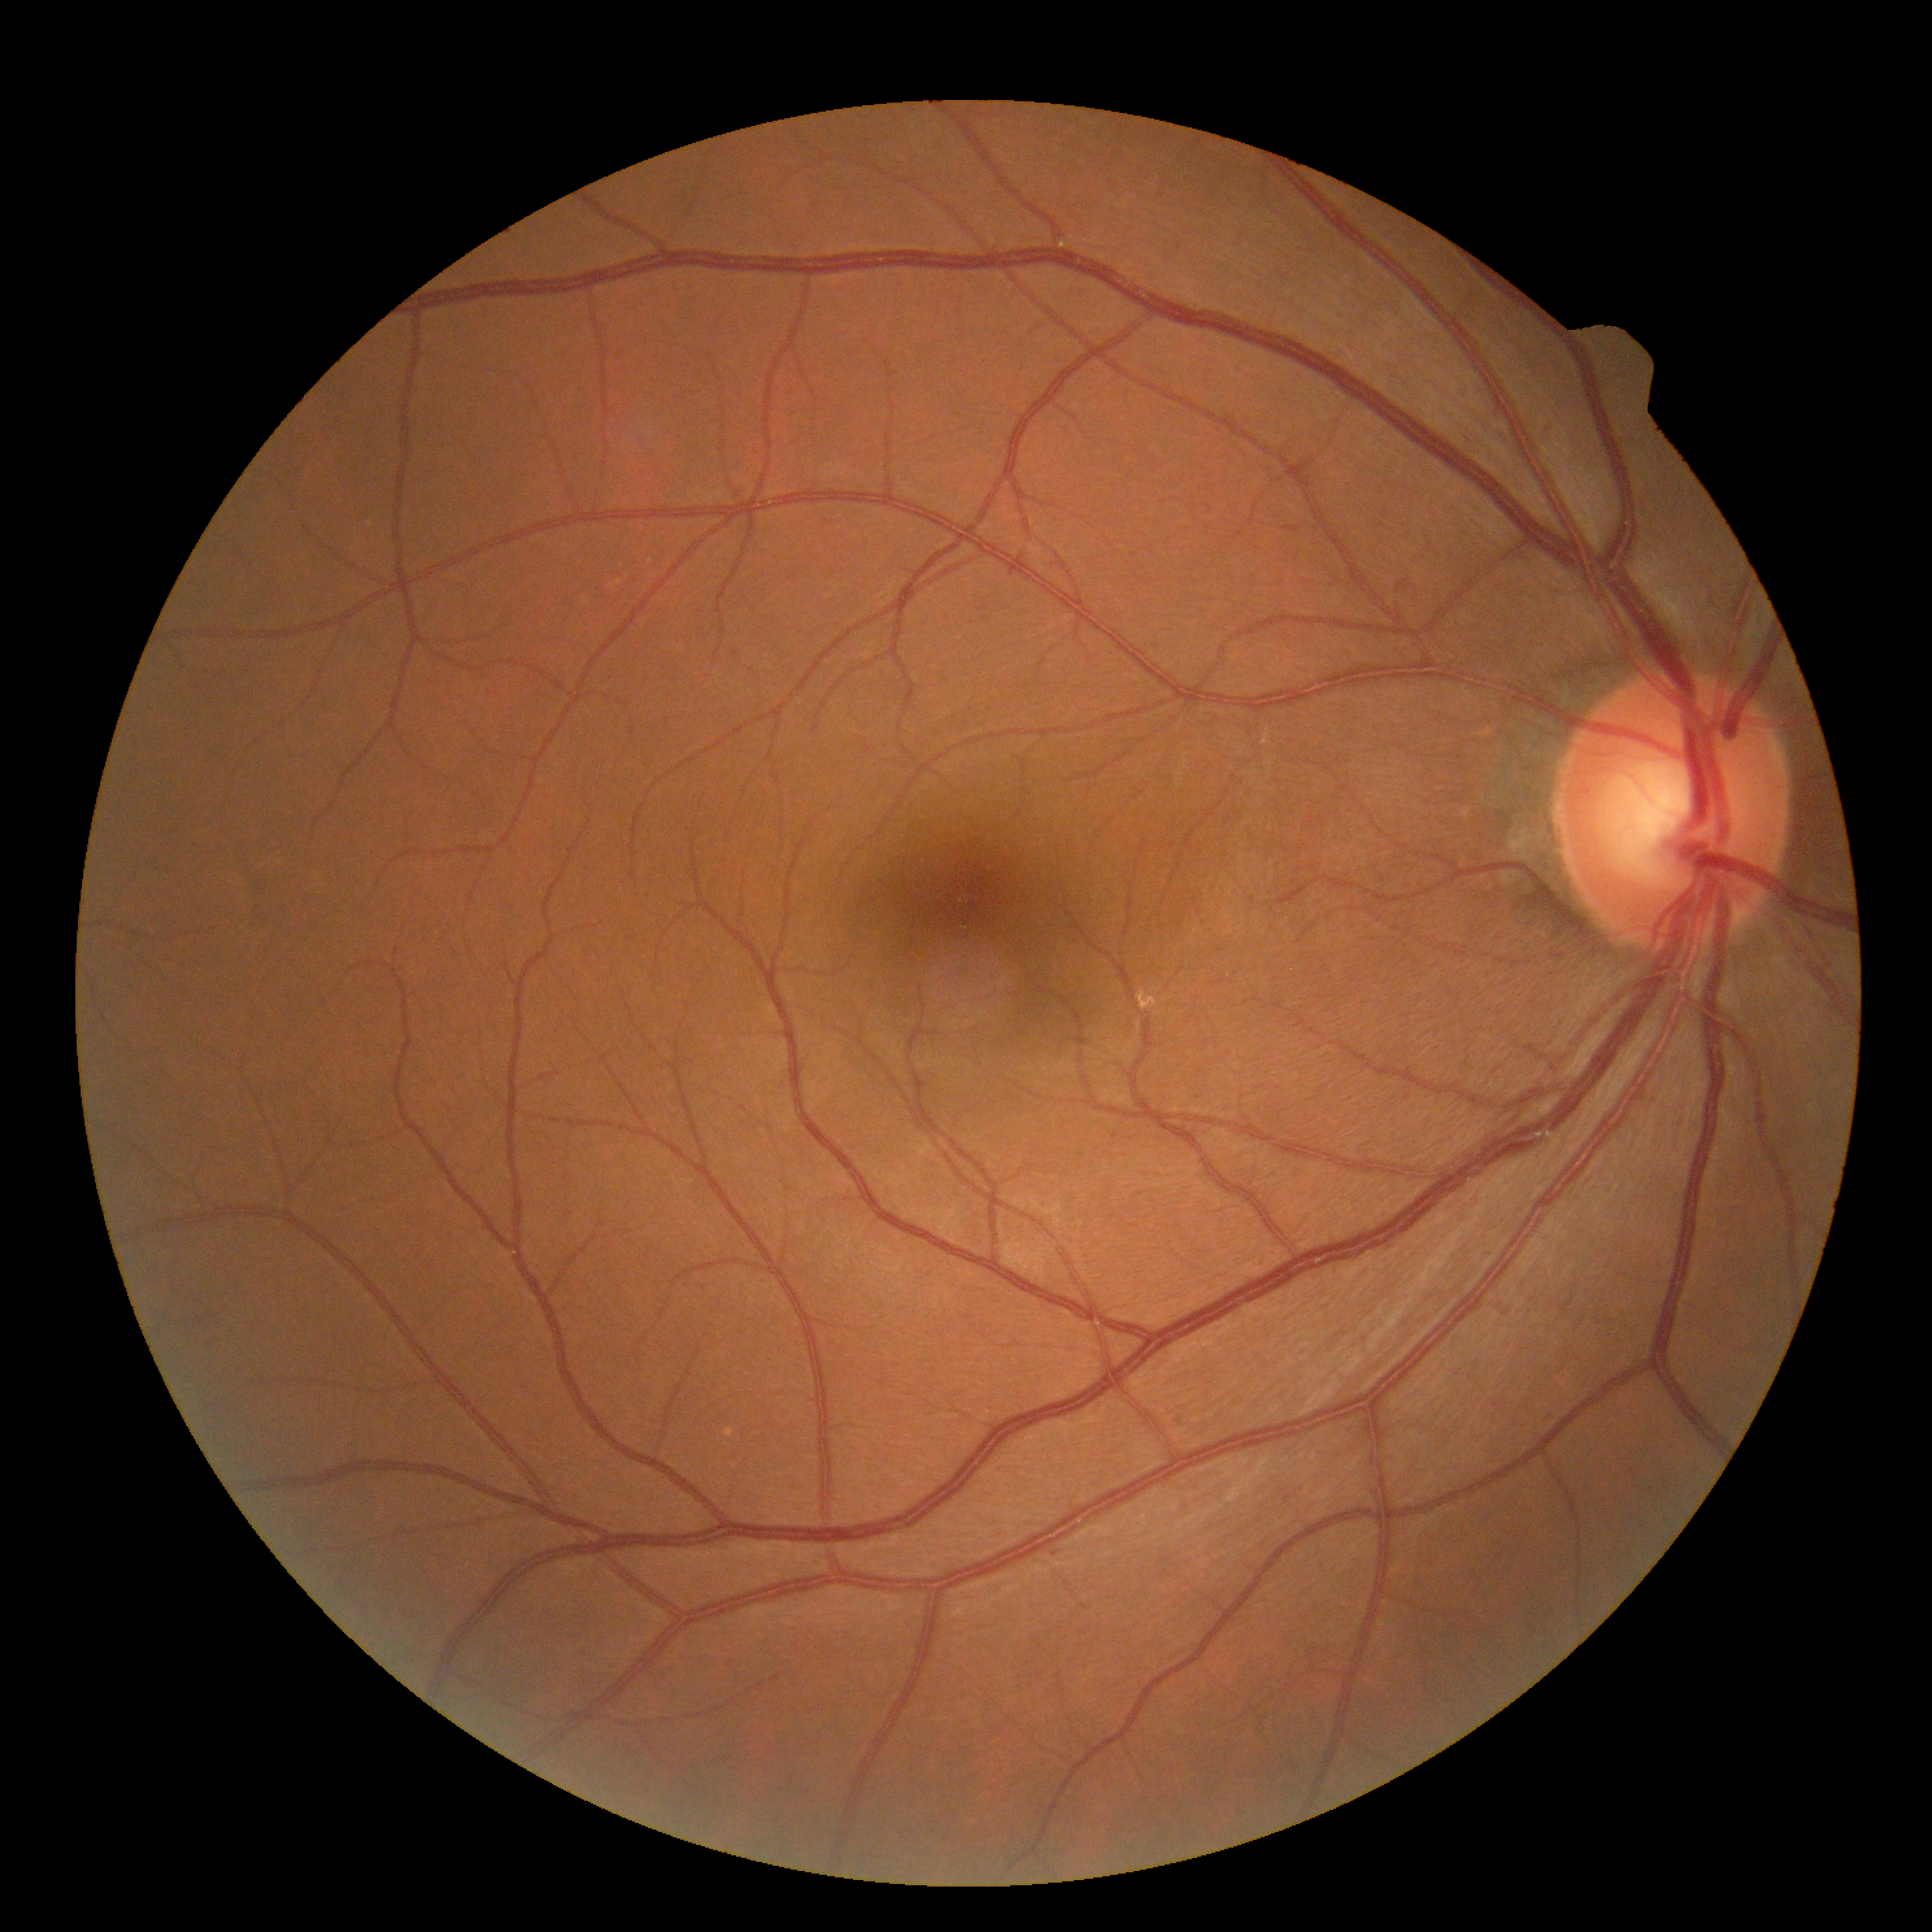 DR impression@no apparent DR, DR@grade 0 (no apparent retinopathy).